2352x1568; 45° field of view; color fundus image.
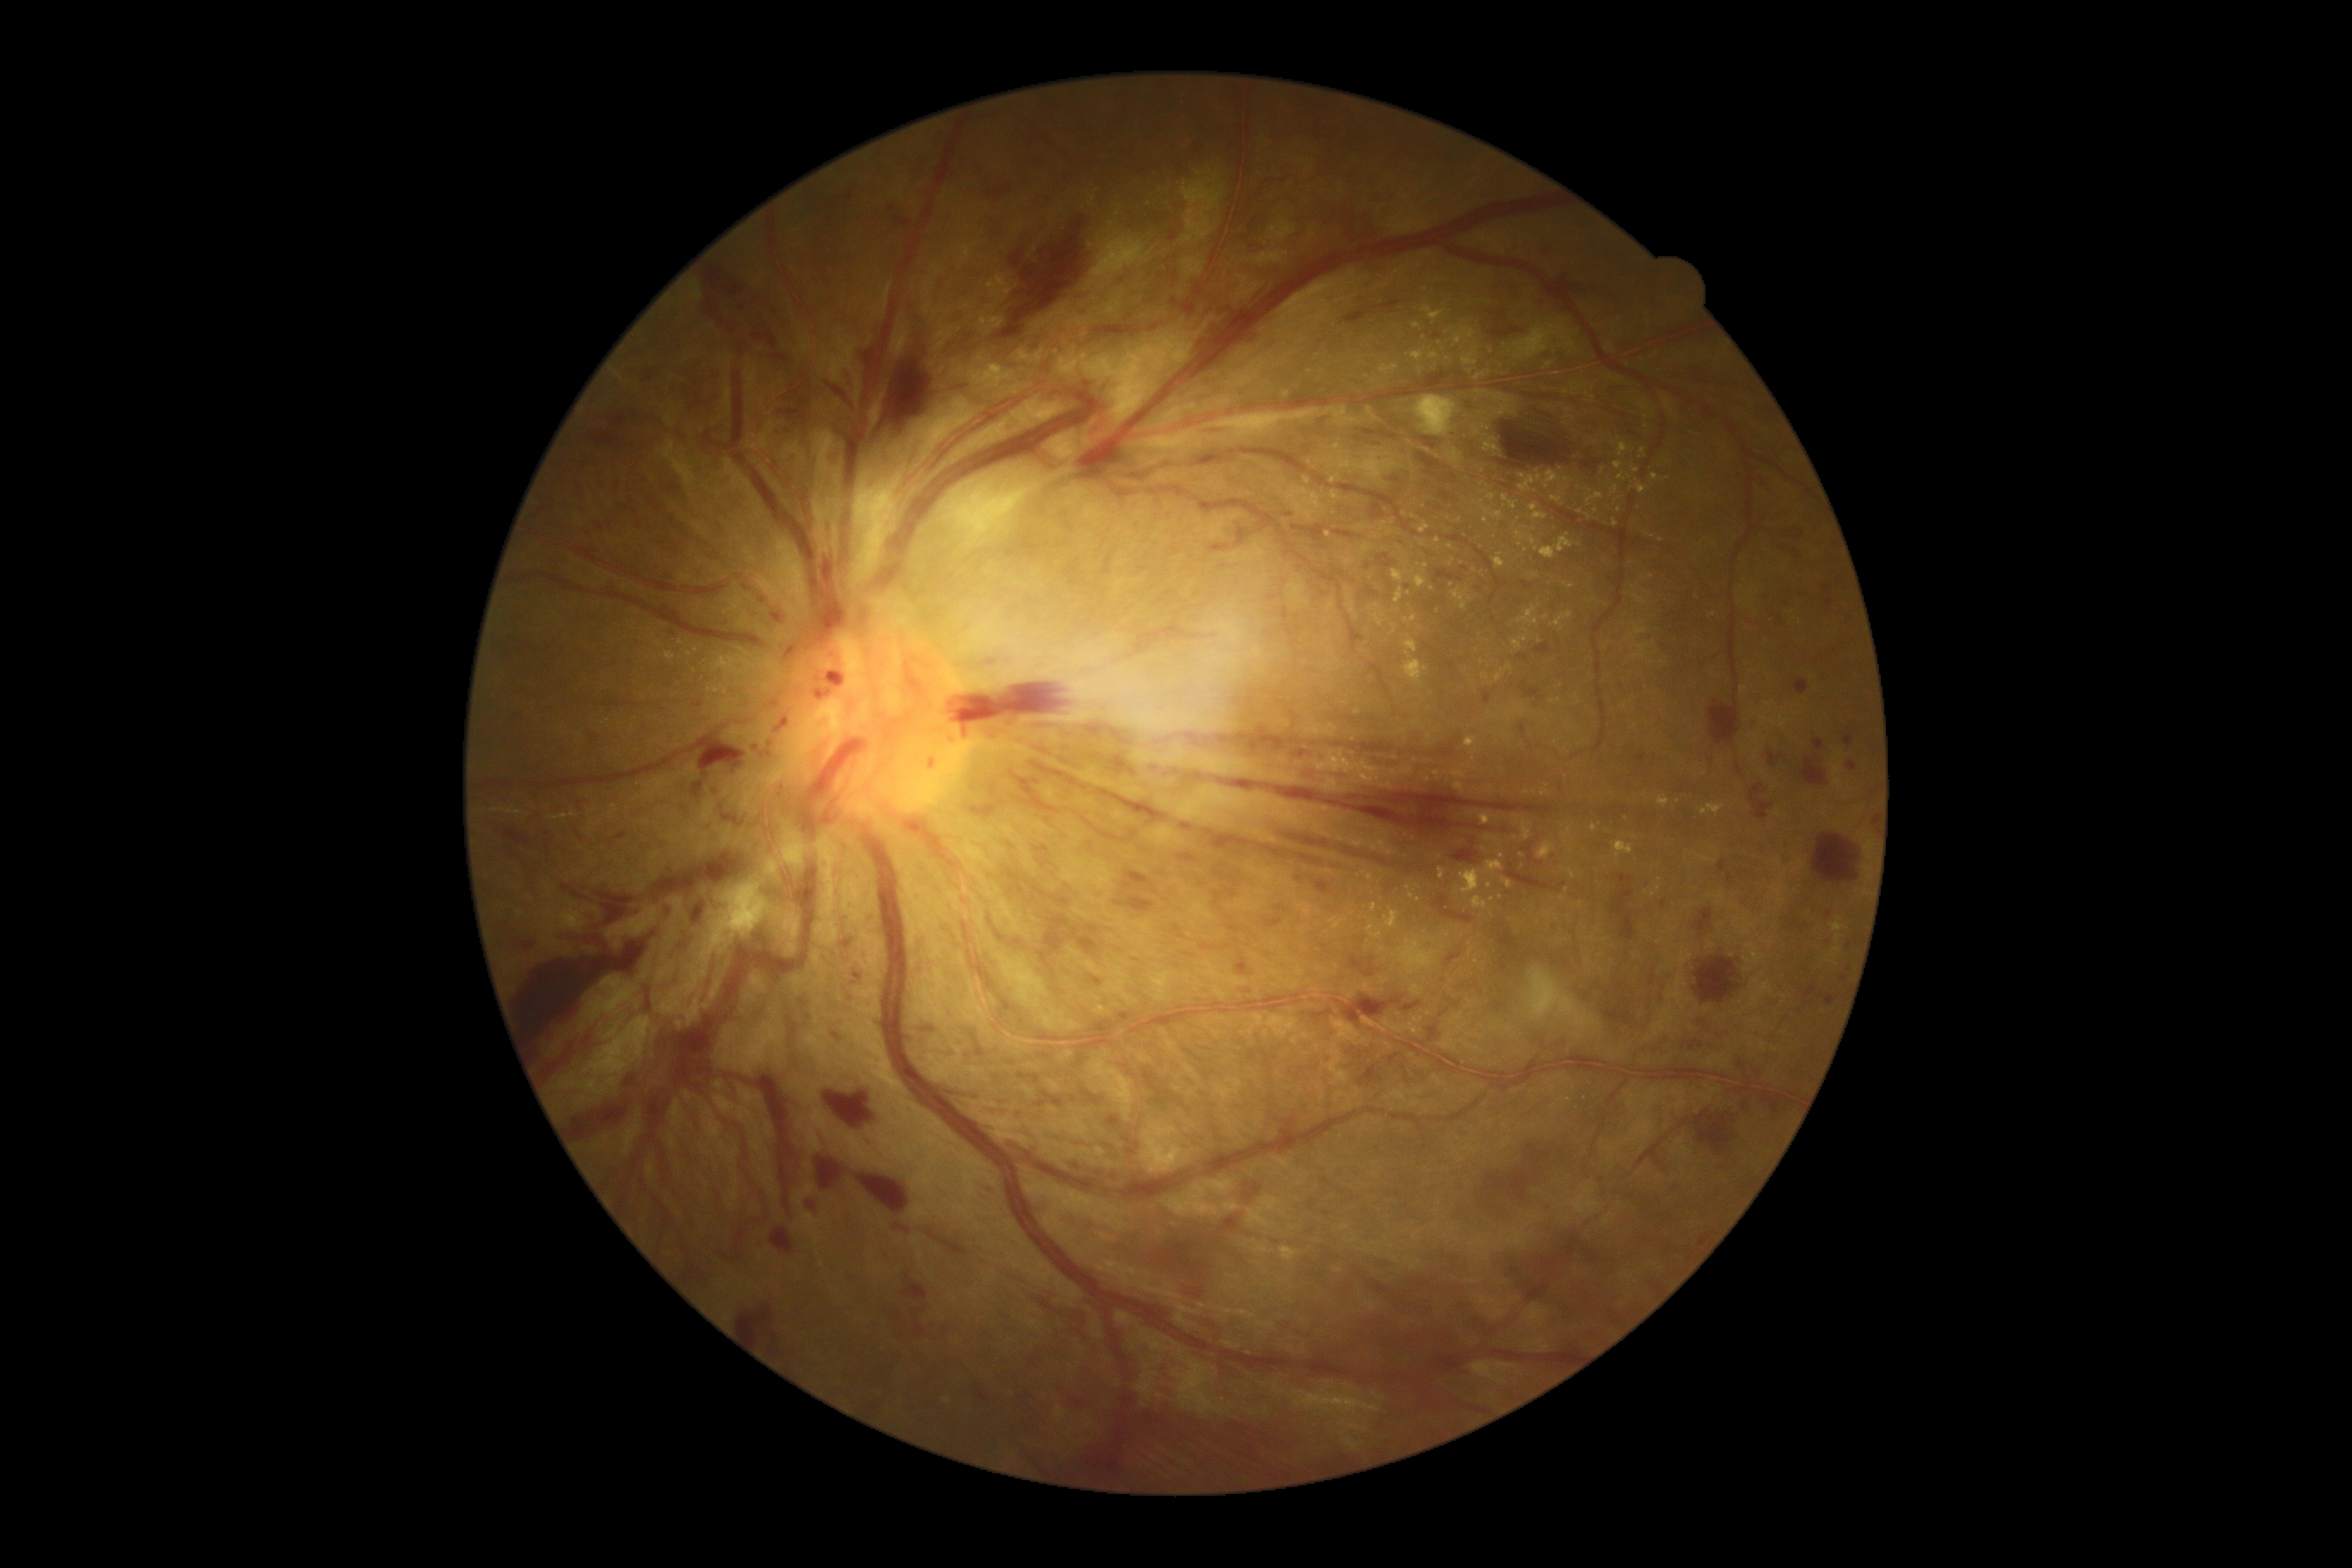
{"partial": true, "dr_grade": 4, "dr_grade_name": "PDR", "lesions": {"he": [[1008, 231, 1031, 267], [1743, 1101, 1749, 1110], [1538, 1139, 1557, 1170], [785, 647, 793, 665], [1689, 1039, 1705, 1051], [1369, 1381, 1479, 1452], [859, 1175, 910, 1215], [848, 190, 855, 202], [1717, 861, 1727, 873], [971, 804, 998, 819], [769, 609, 785, 625], [971, 162, 983, 180], [1285, 513, 1294, 518], [1180, 1311, 1227, 1340], [1036, 847, 1050, 852], [692, 902, 704, 924], [805, 1199, 823, 1220], [1010, 938, 1022, 946]], "he_small": [[850, 998]]}}